Fundus photo · 45° FOV · 2352x1568px:
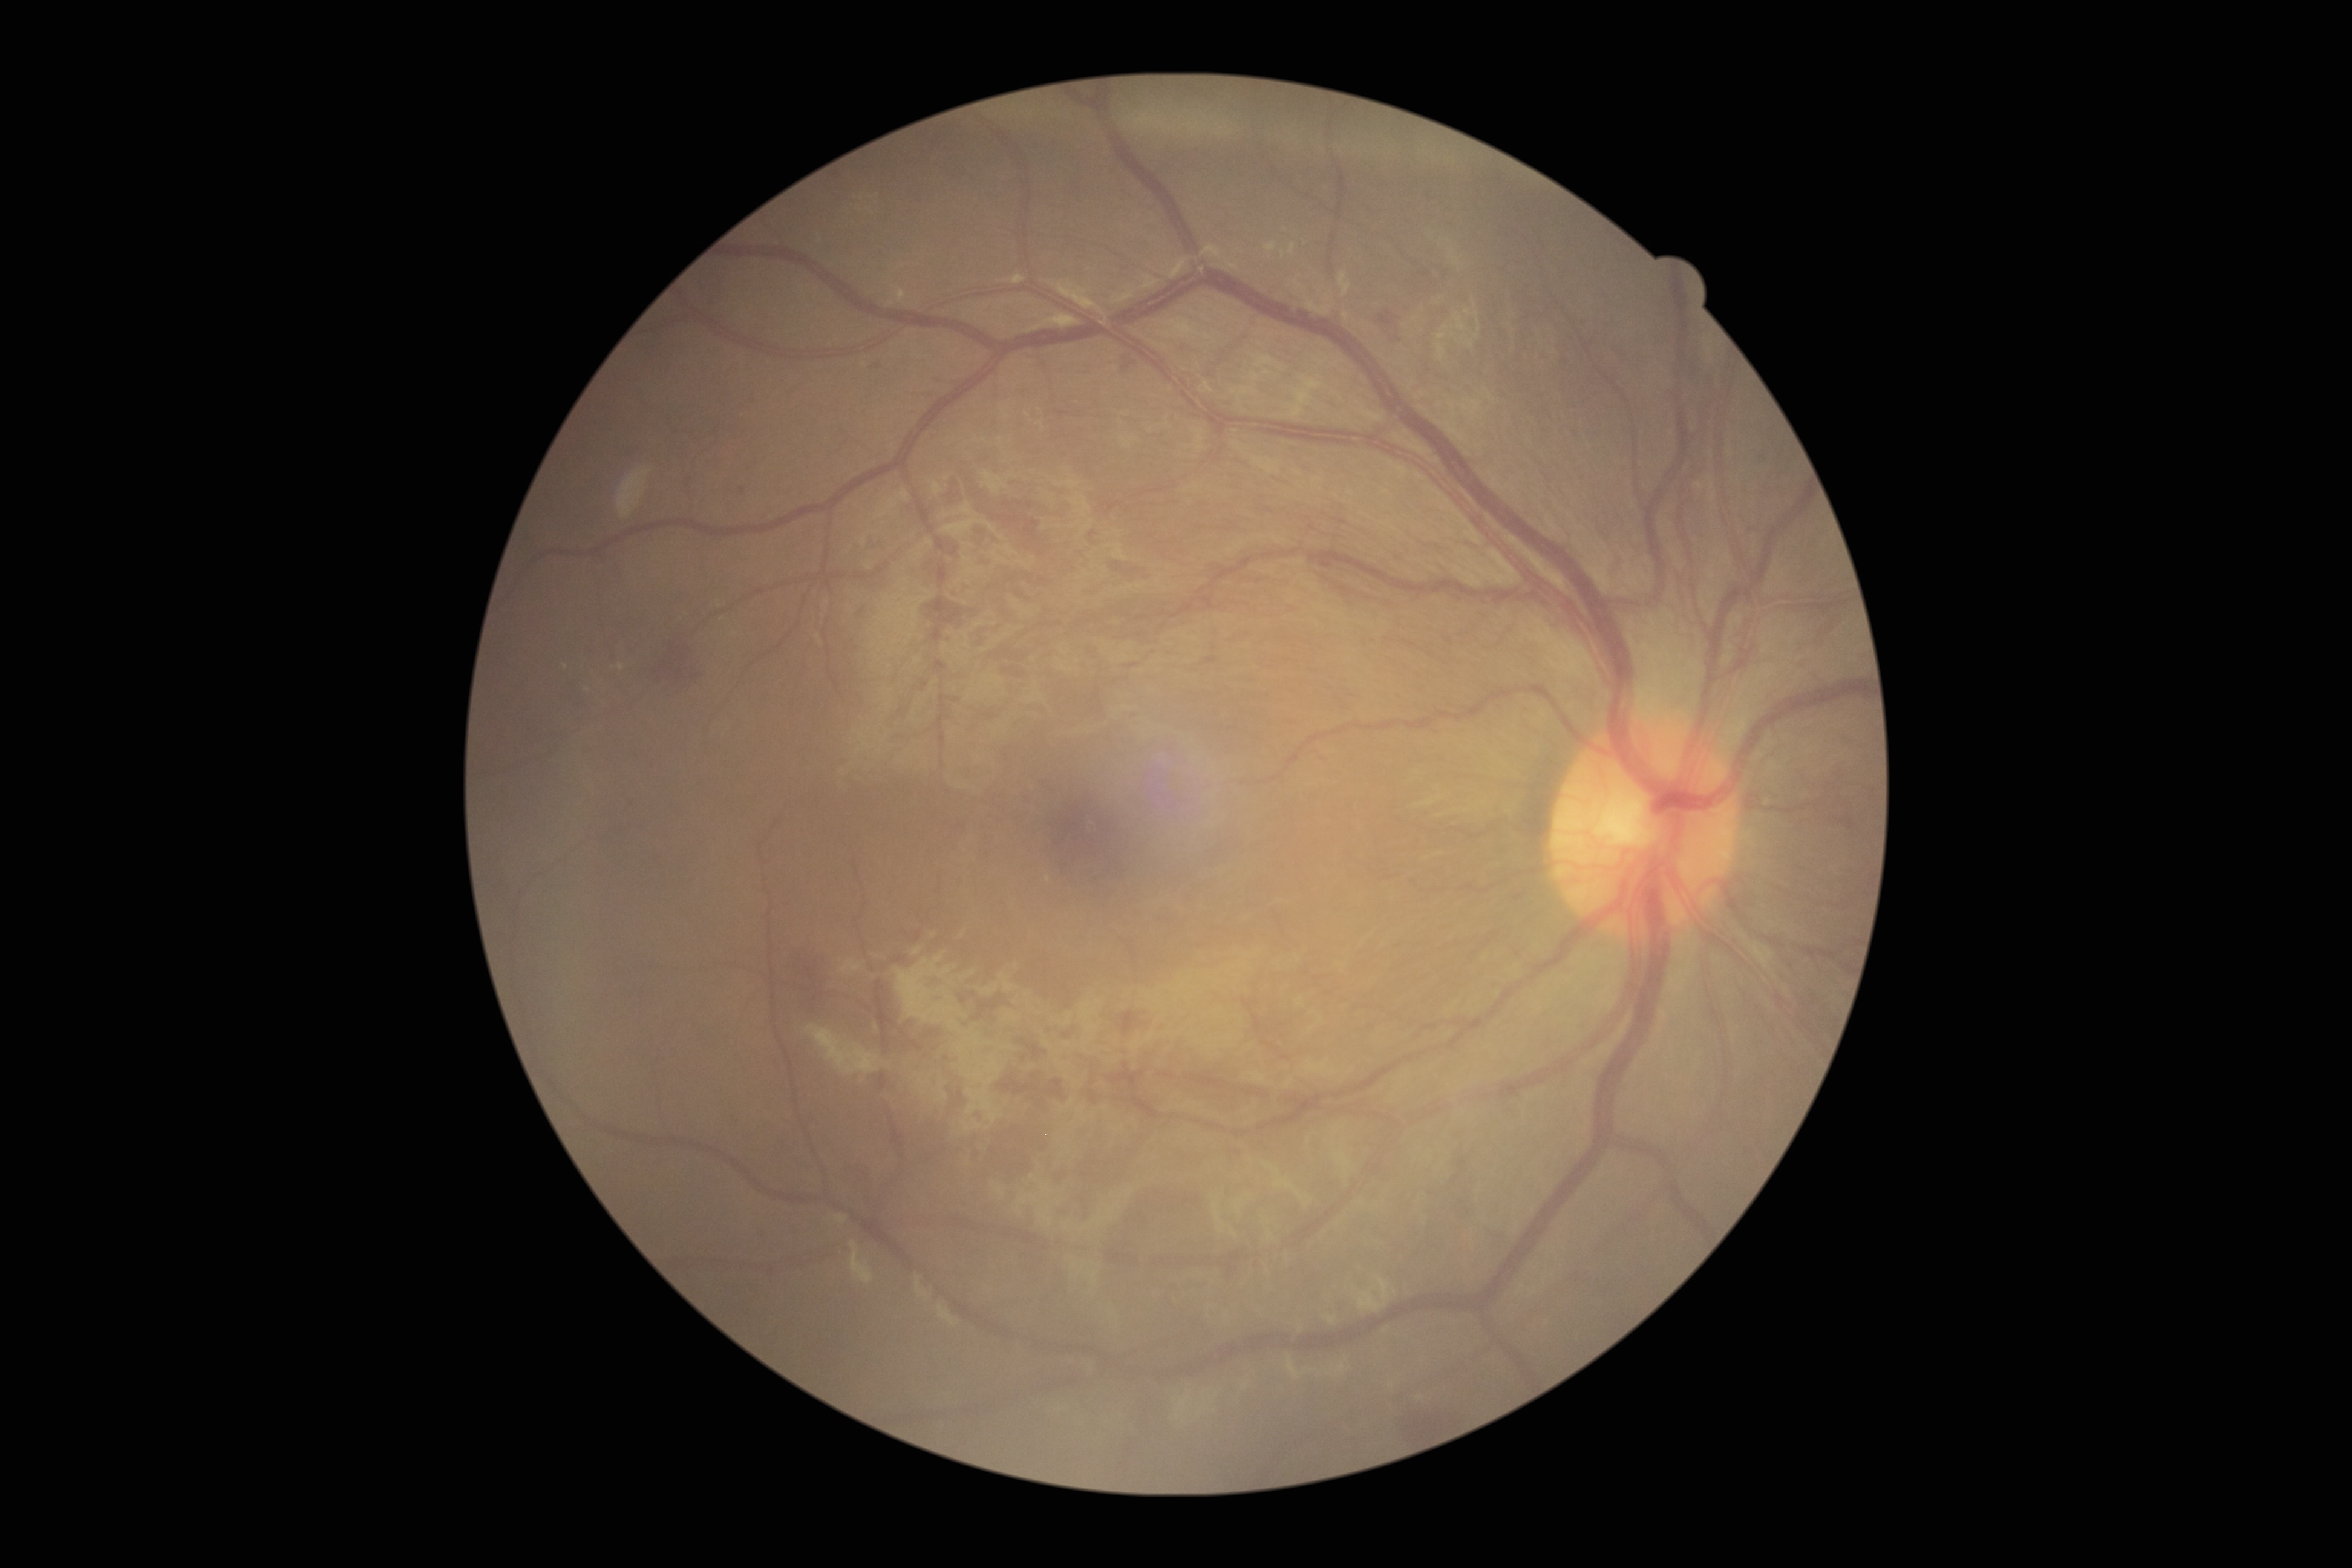 Diabetic retinopathy (DR) is moderate non-proliferative diabetic retinopathy (grade 2)
Findings:
* hemorrhages (HEs): (left=1114, top=359, right=1140, bottom=379), (left=1398, top=1400, right=1446, bottom=1446), (left=872, top=360, right=884, bottom=370), (left=1379, top=312, right=1398, bottom=328), (left=652, top=647, right=710, bottom=699)
* HEs (small, approximate centers) near [x=743, y=490], [x=1398, y=340]
* soft exudates (SEs): none detected
* EXs (small, approximate centers) near [x=622, y=668], [x=566, y=668], [x=588, y=691]
* microaneurysms (MAs): none detected